45-degree field of view. 1932 x 1916 pixels — 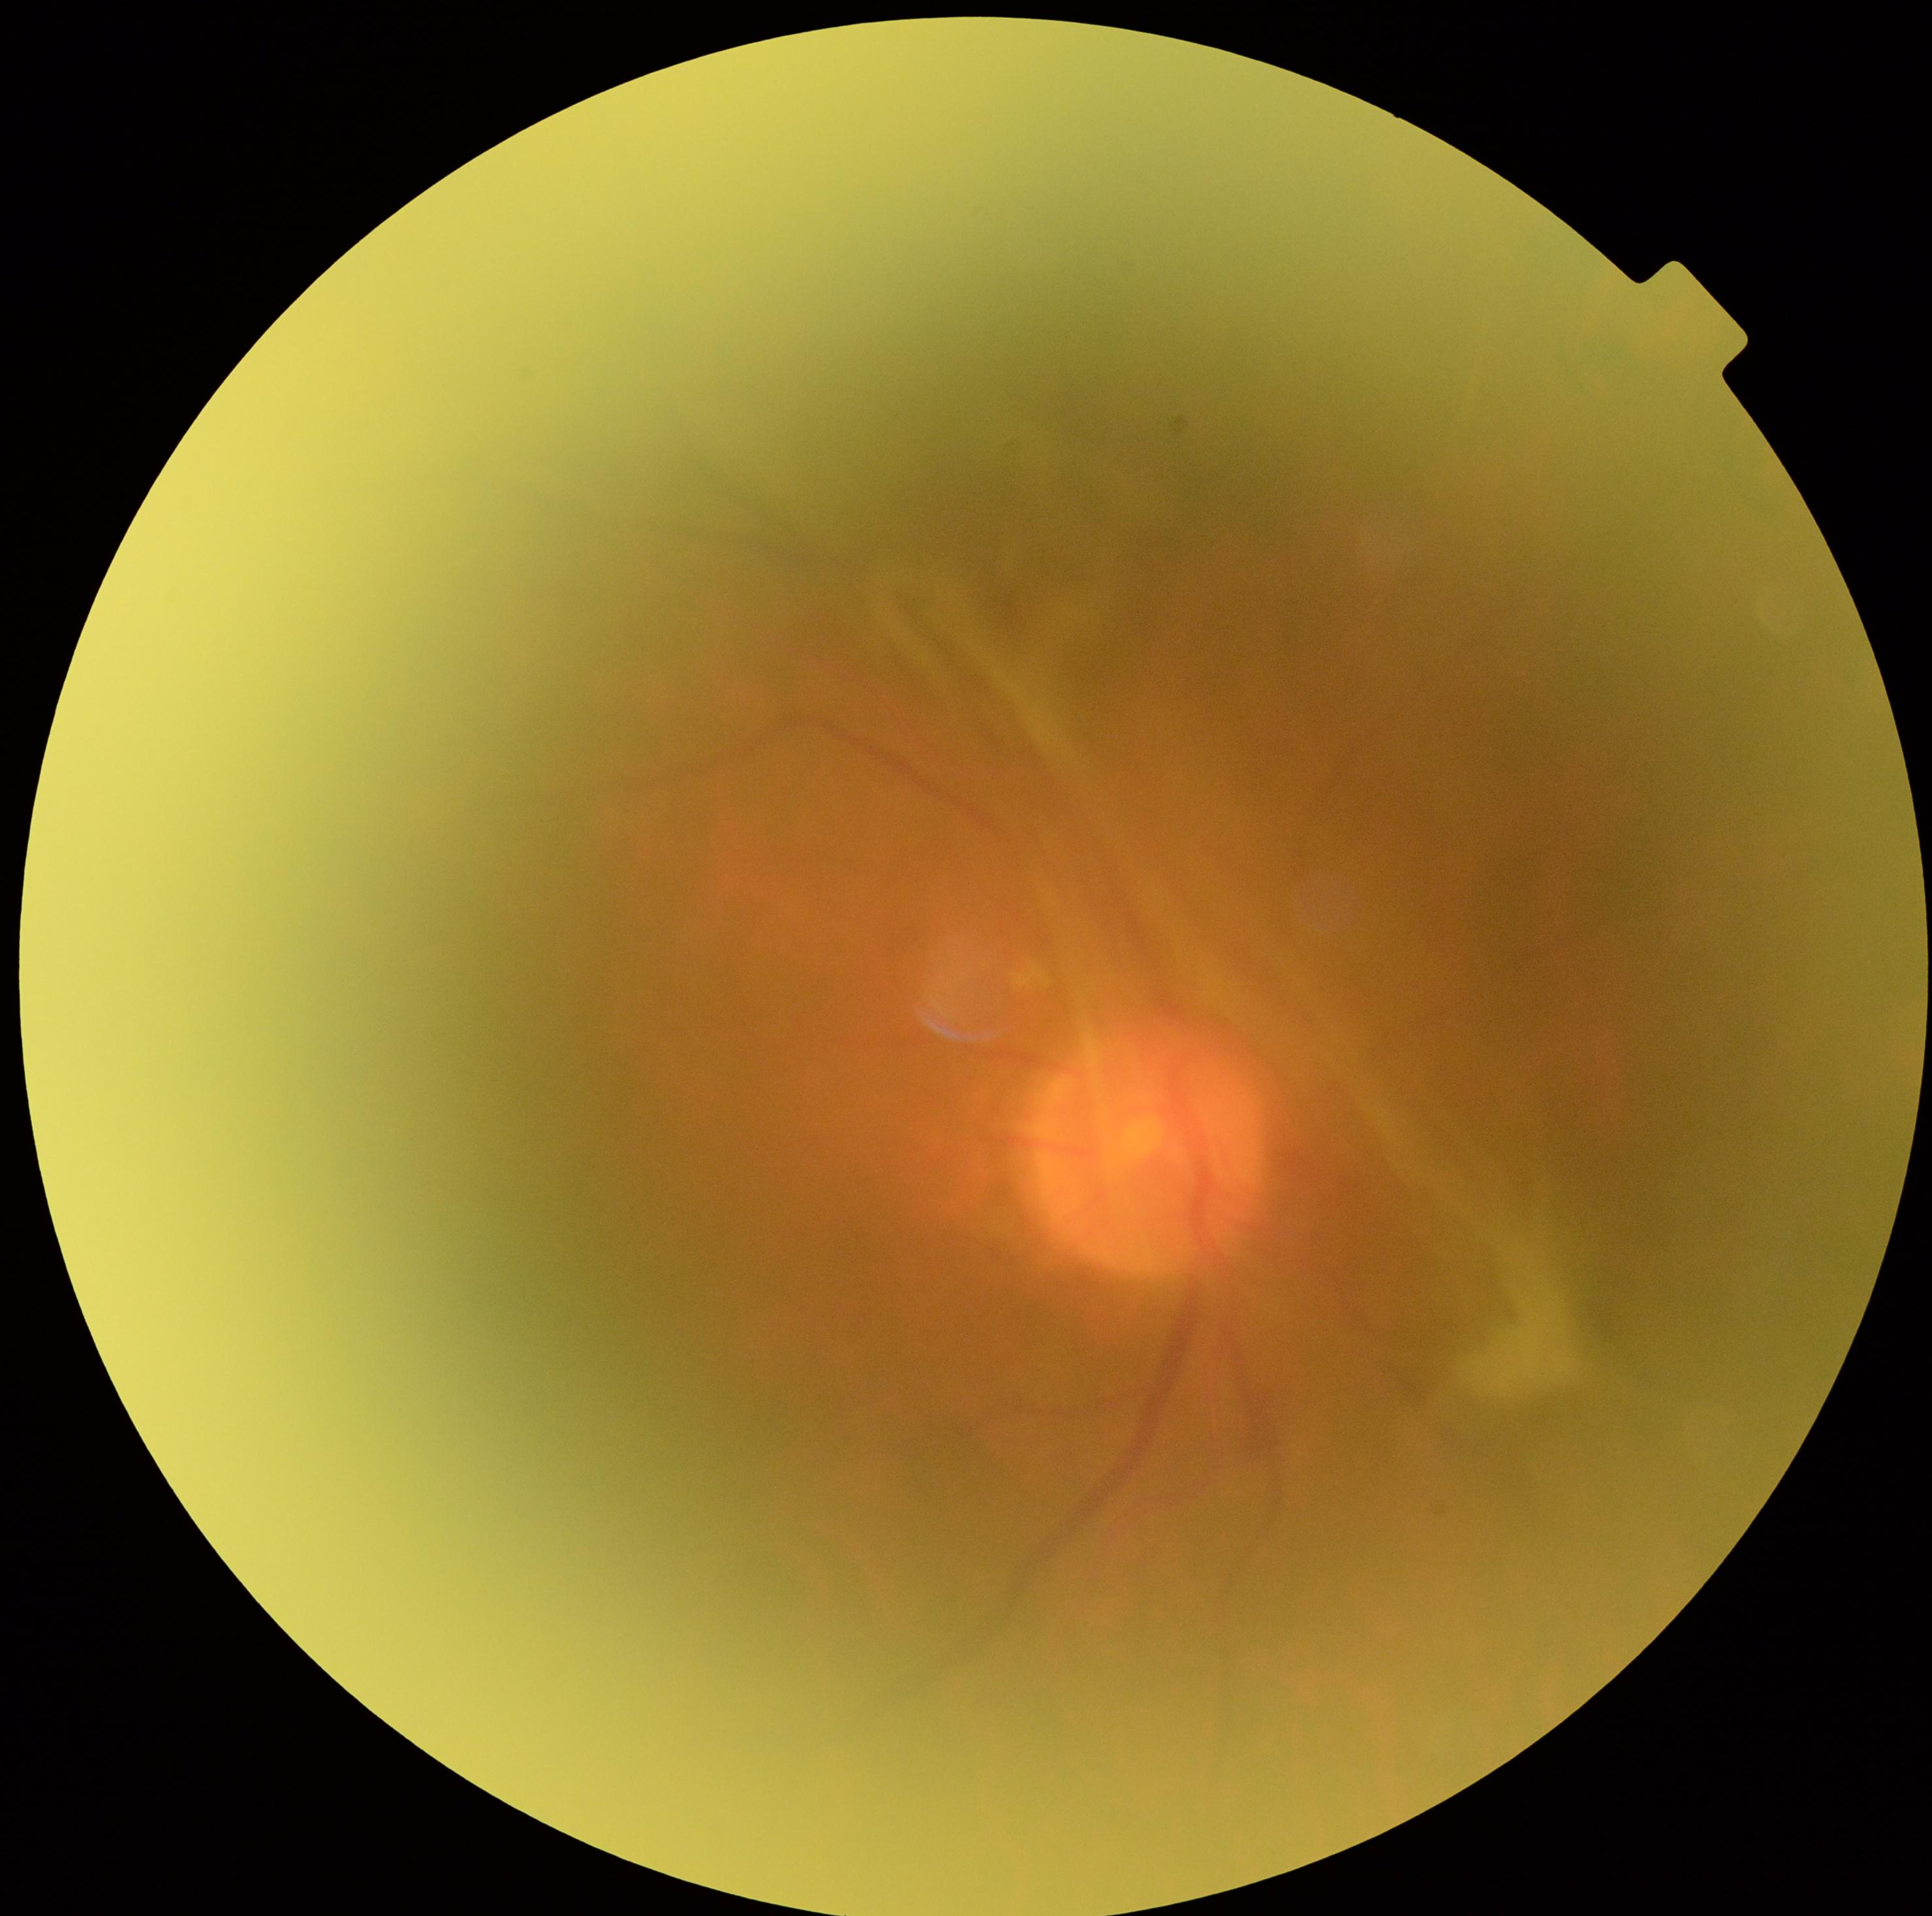 Diabetic retinopathy (DR): grade 4 — neovascularization and/or vitreous/pre-retinal hemorrhage.